30-degree field of view — 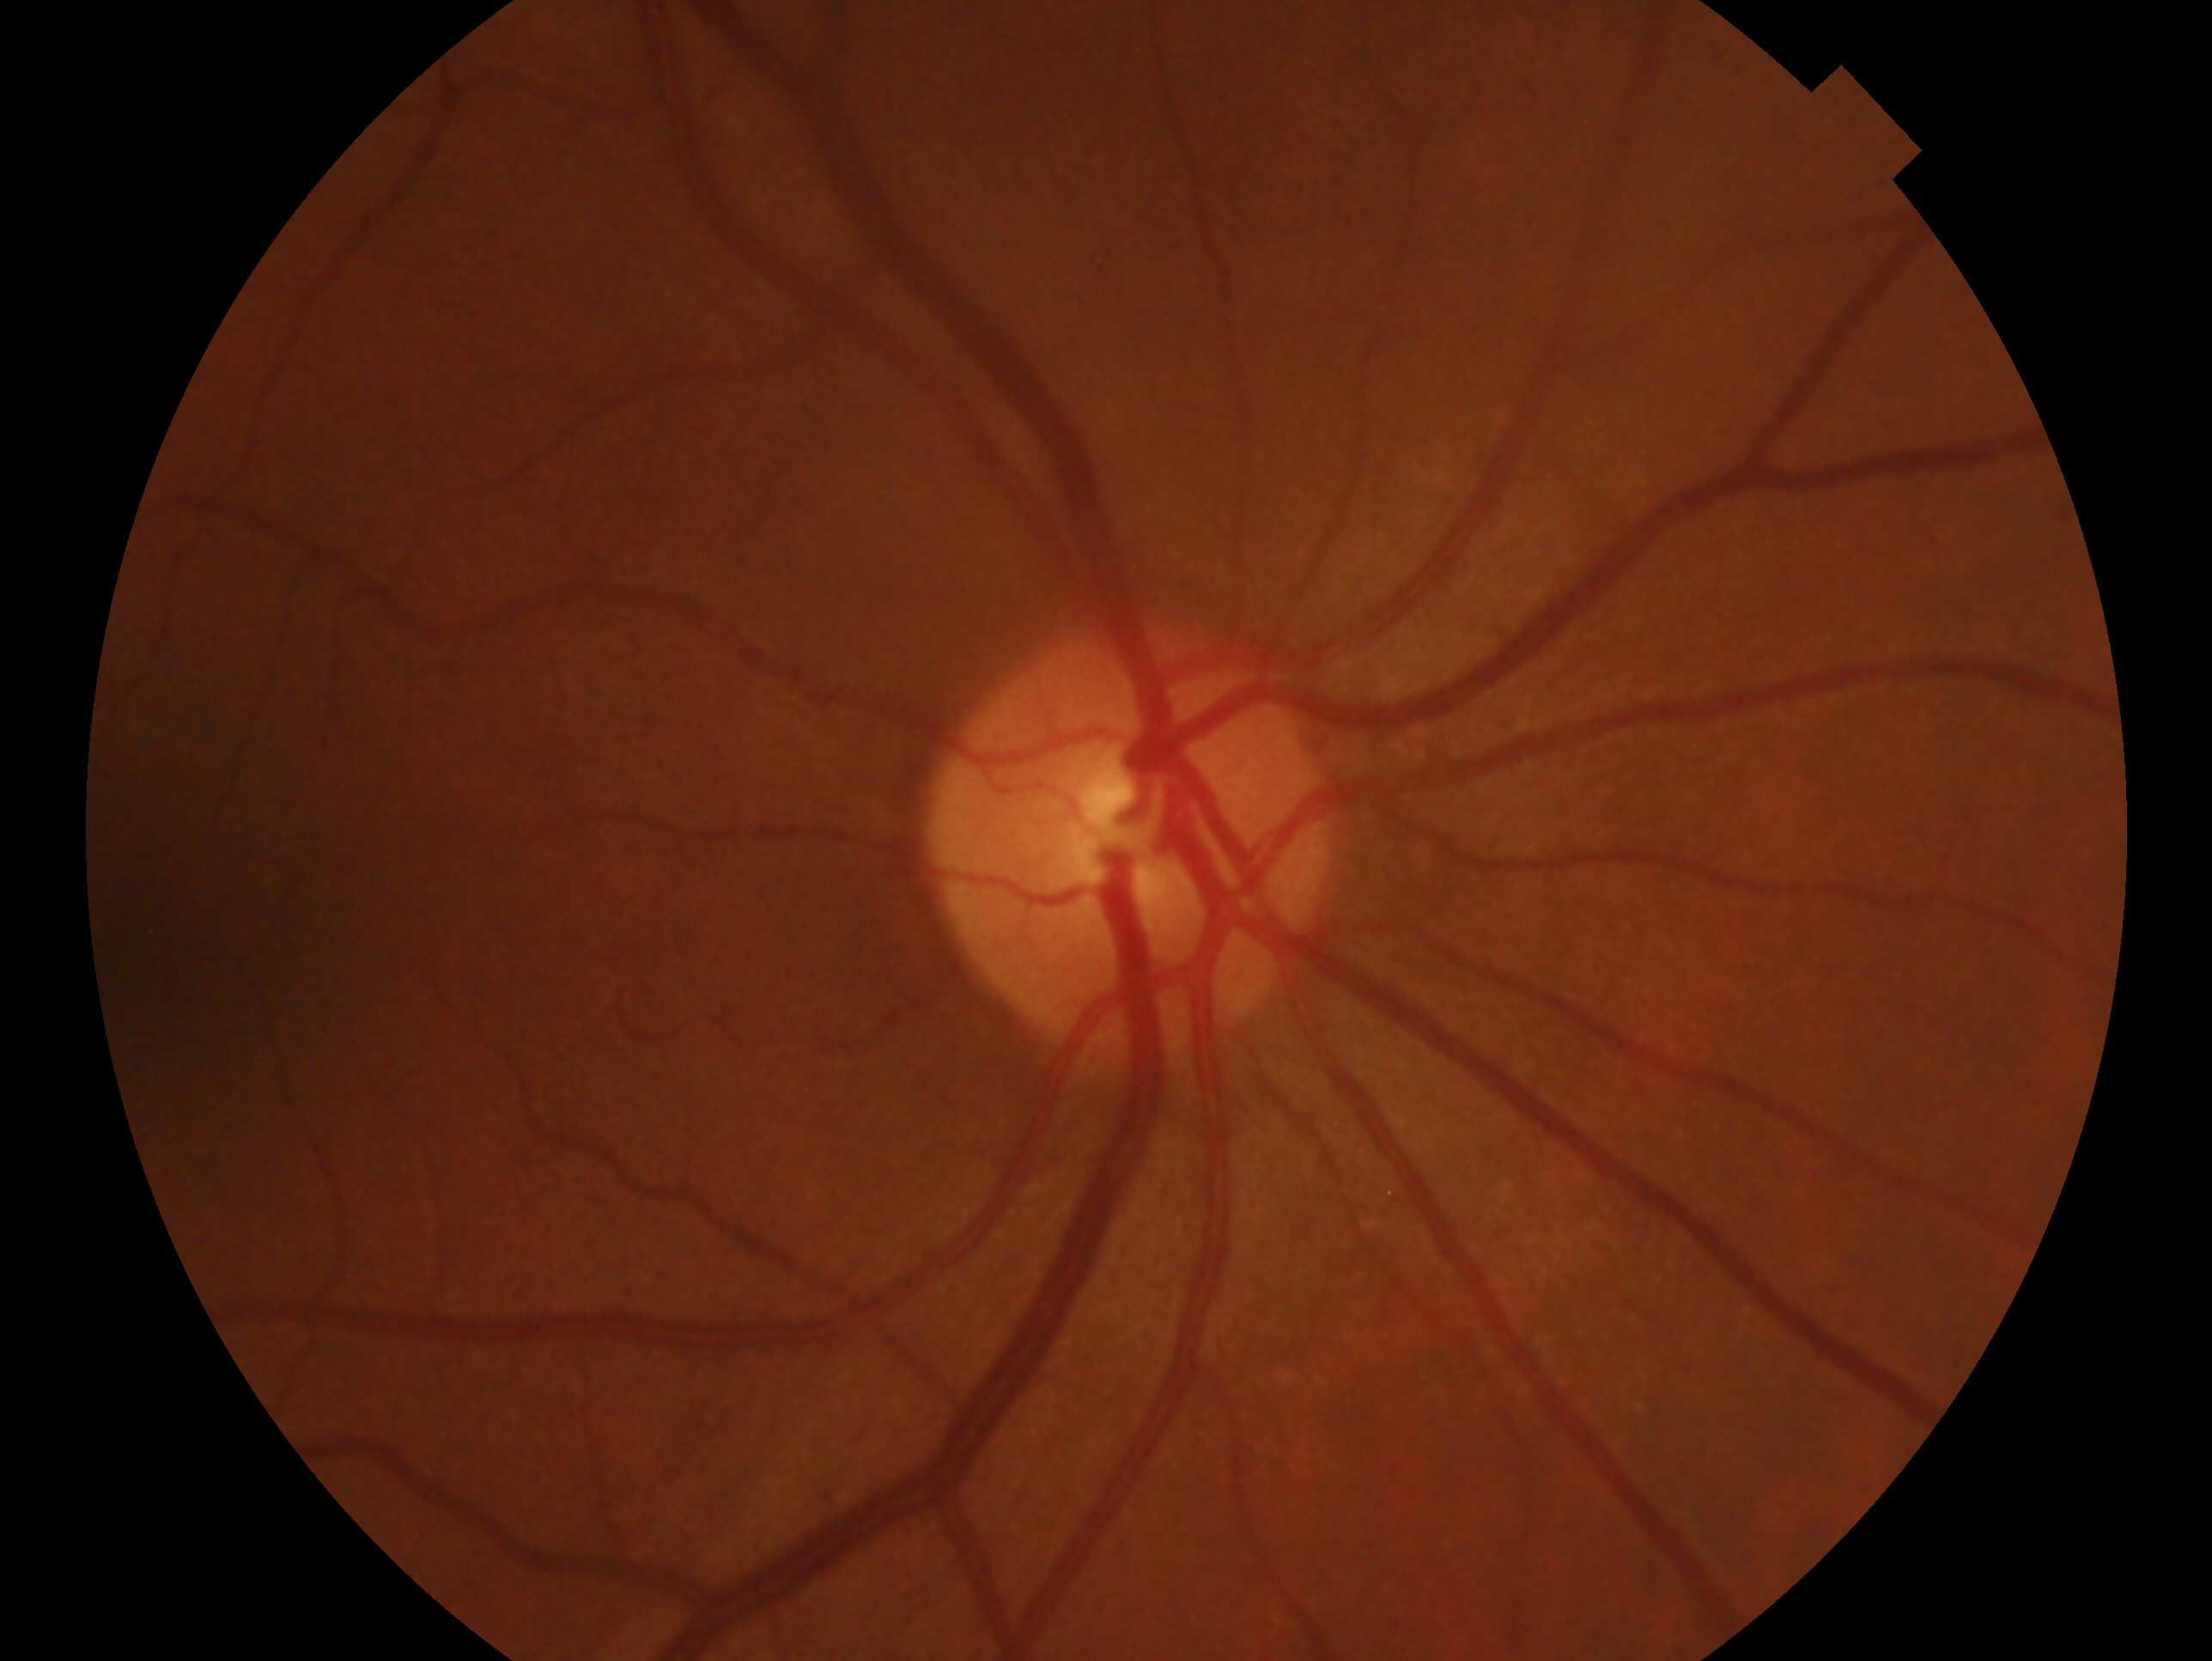 Annotations:
* impression · no glaucomatous findings — no clinical evidence of glaucoma in this eye
* laterality · right